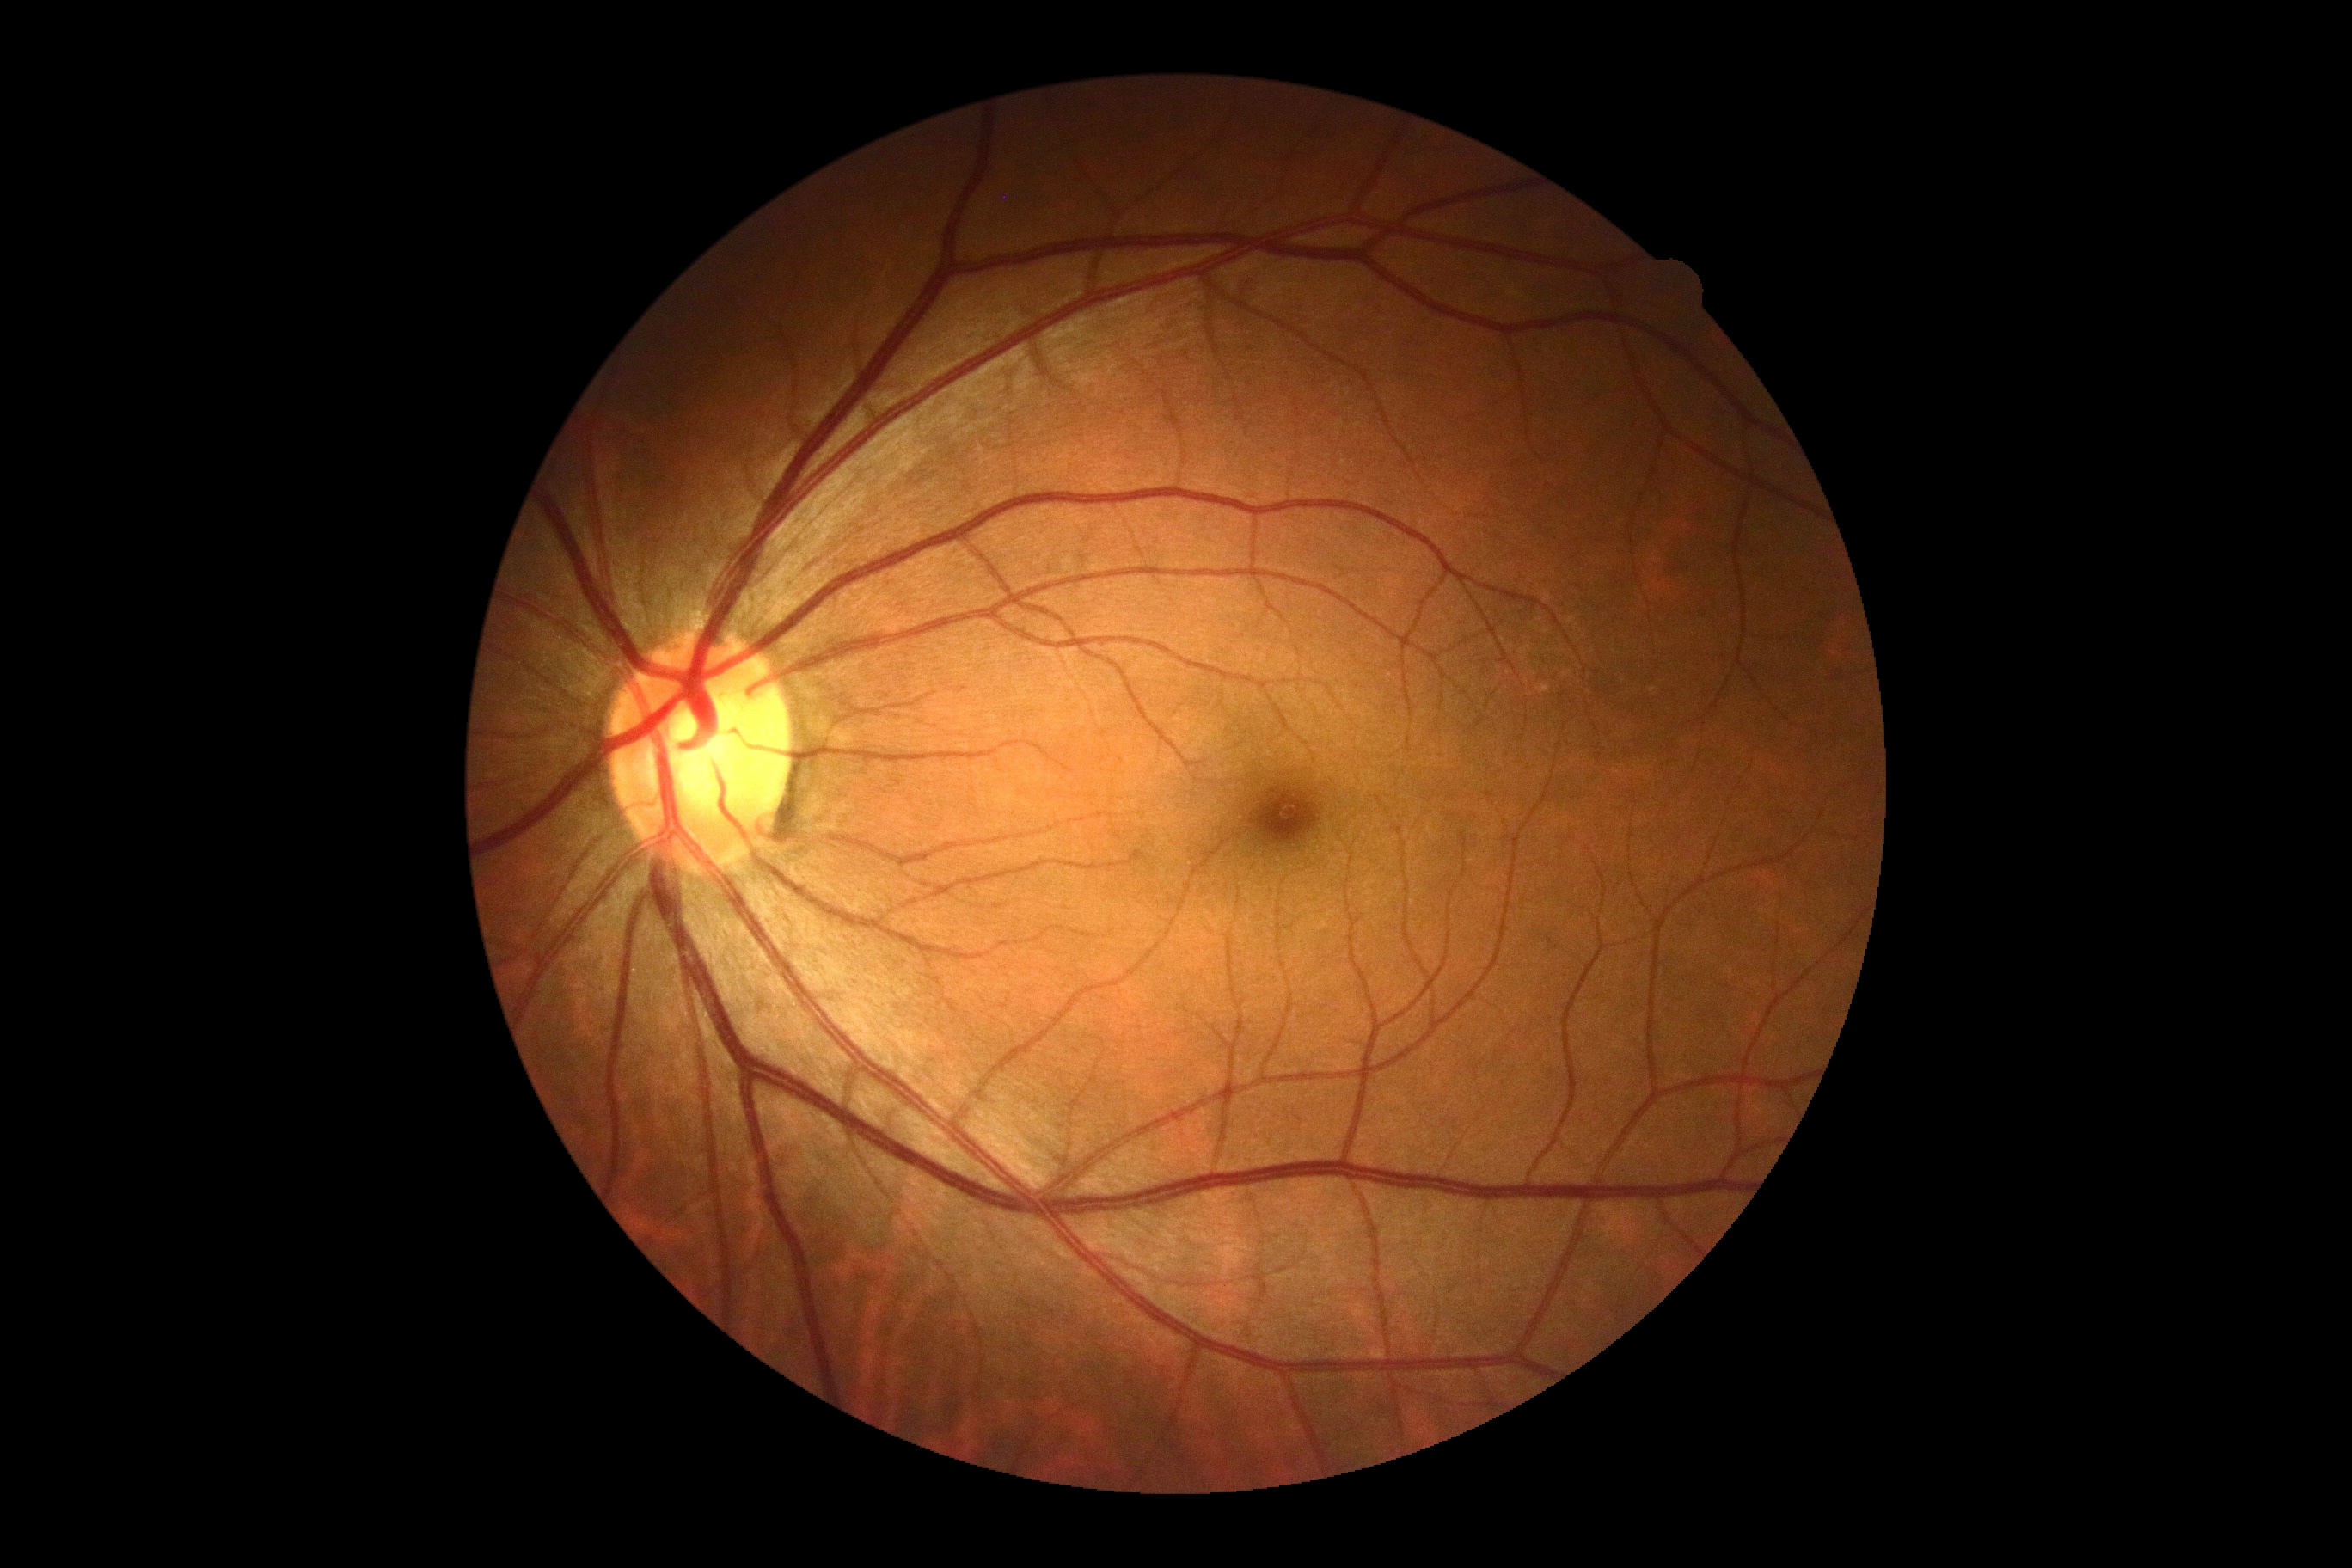

DR severity: 0/4.